Fundus photo · macula-centered
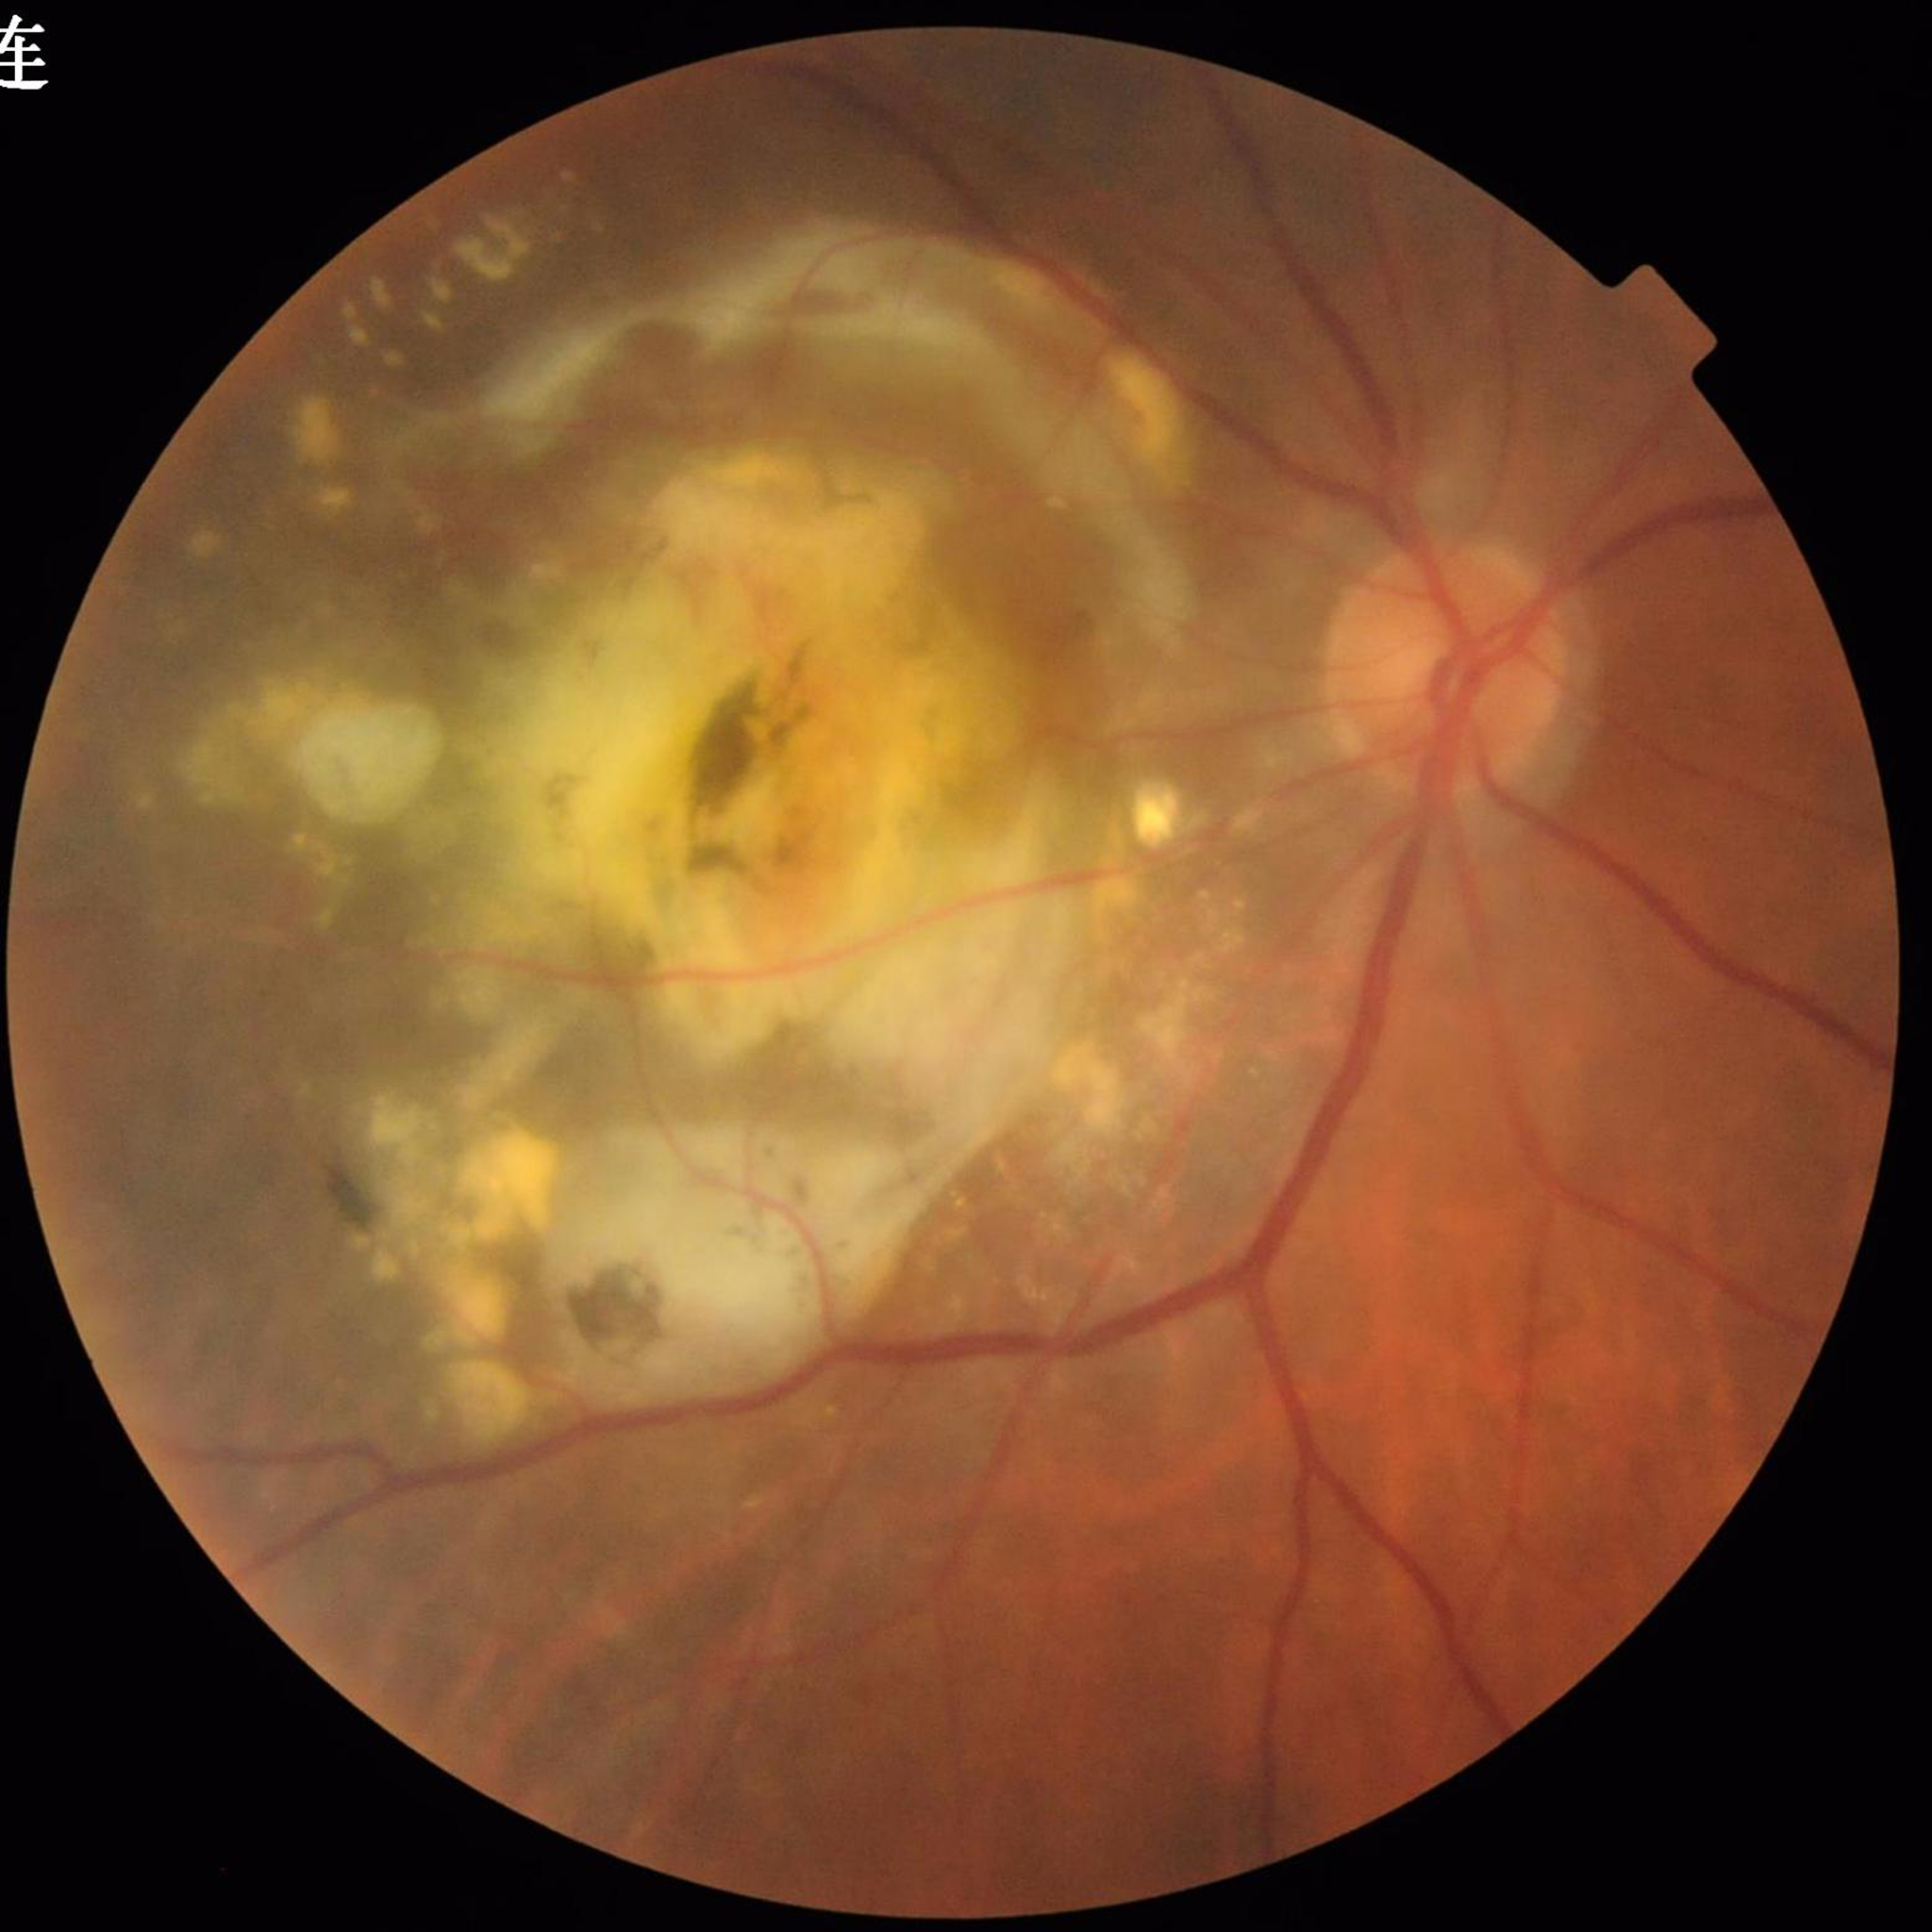

Disease class: DR
Image quality: no blur, contrast adequate, illumination and color satisfactory